Captured on a Topcon TRC-NW8 fundus camera.
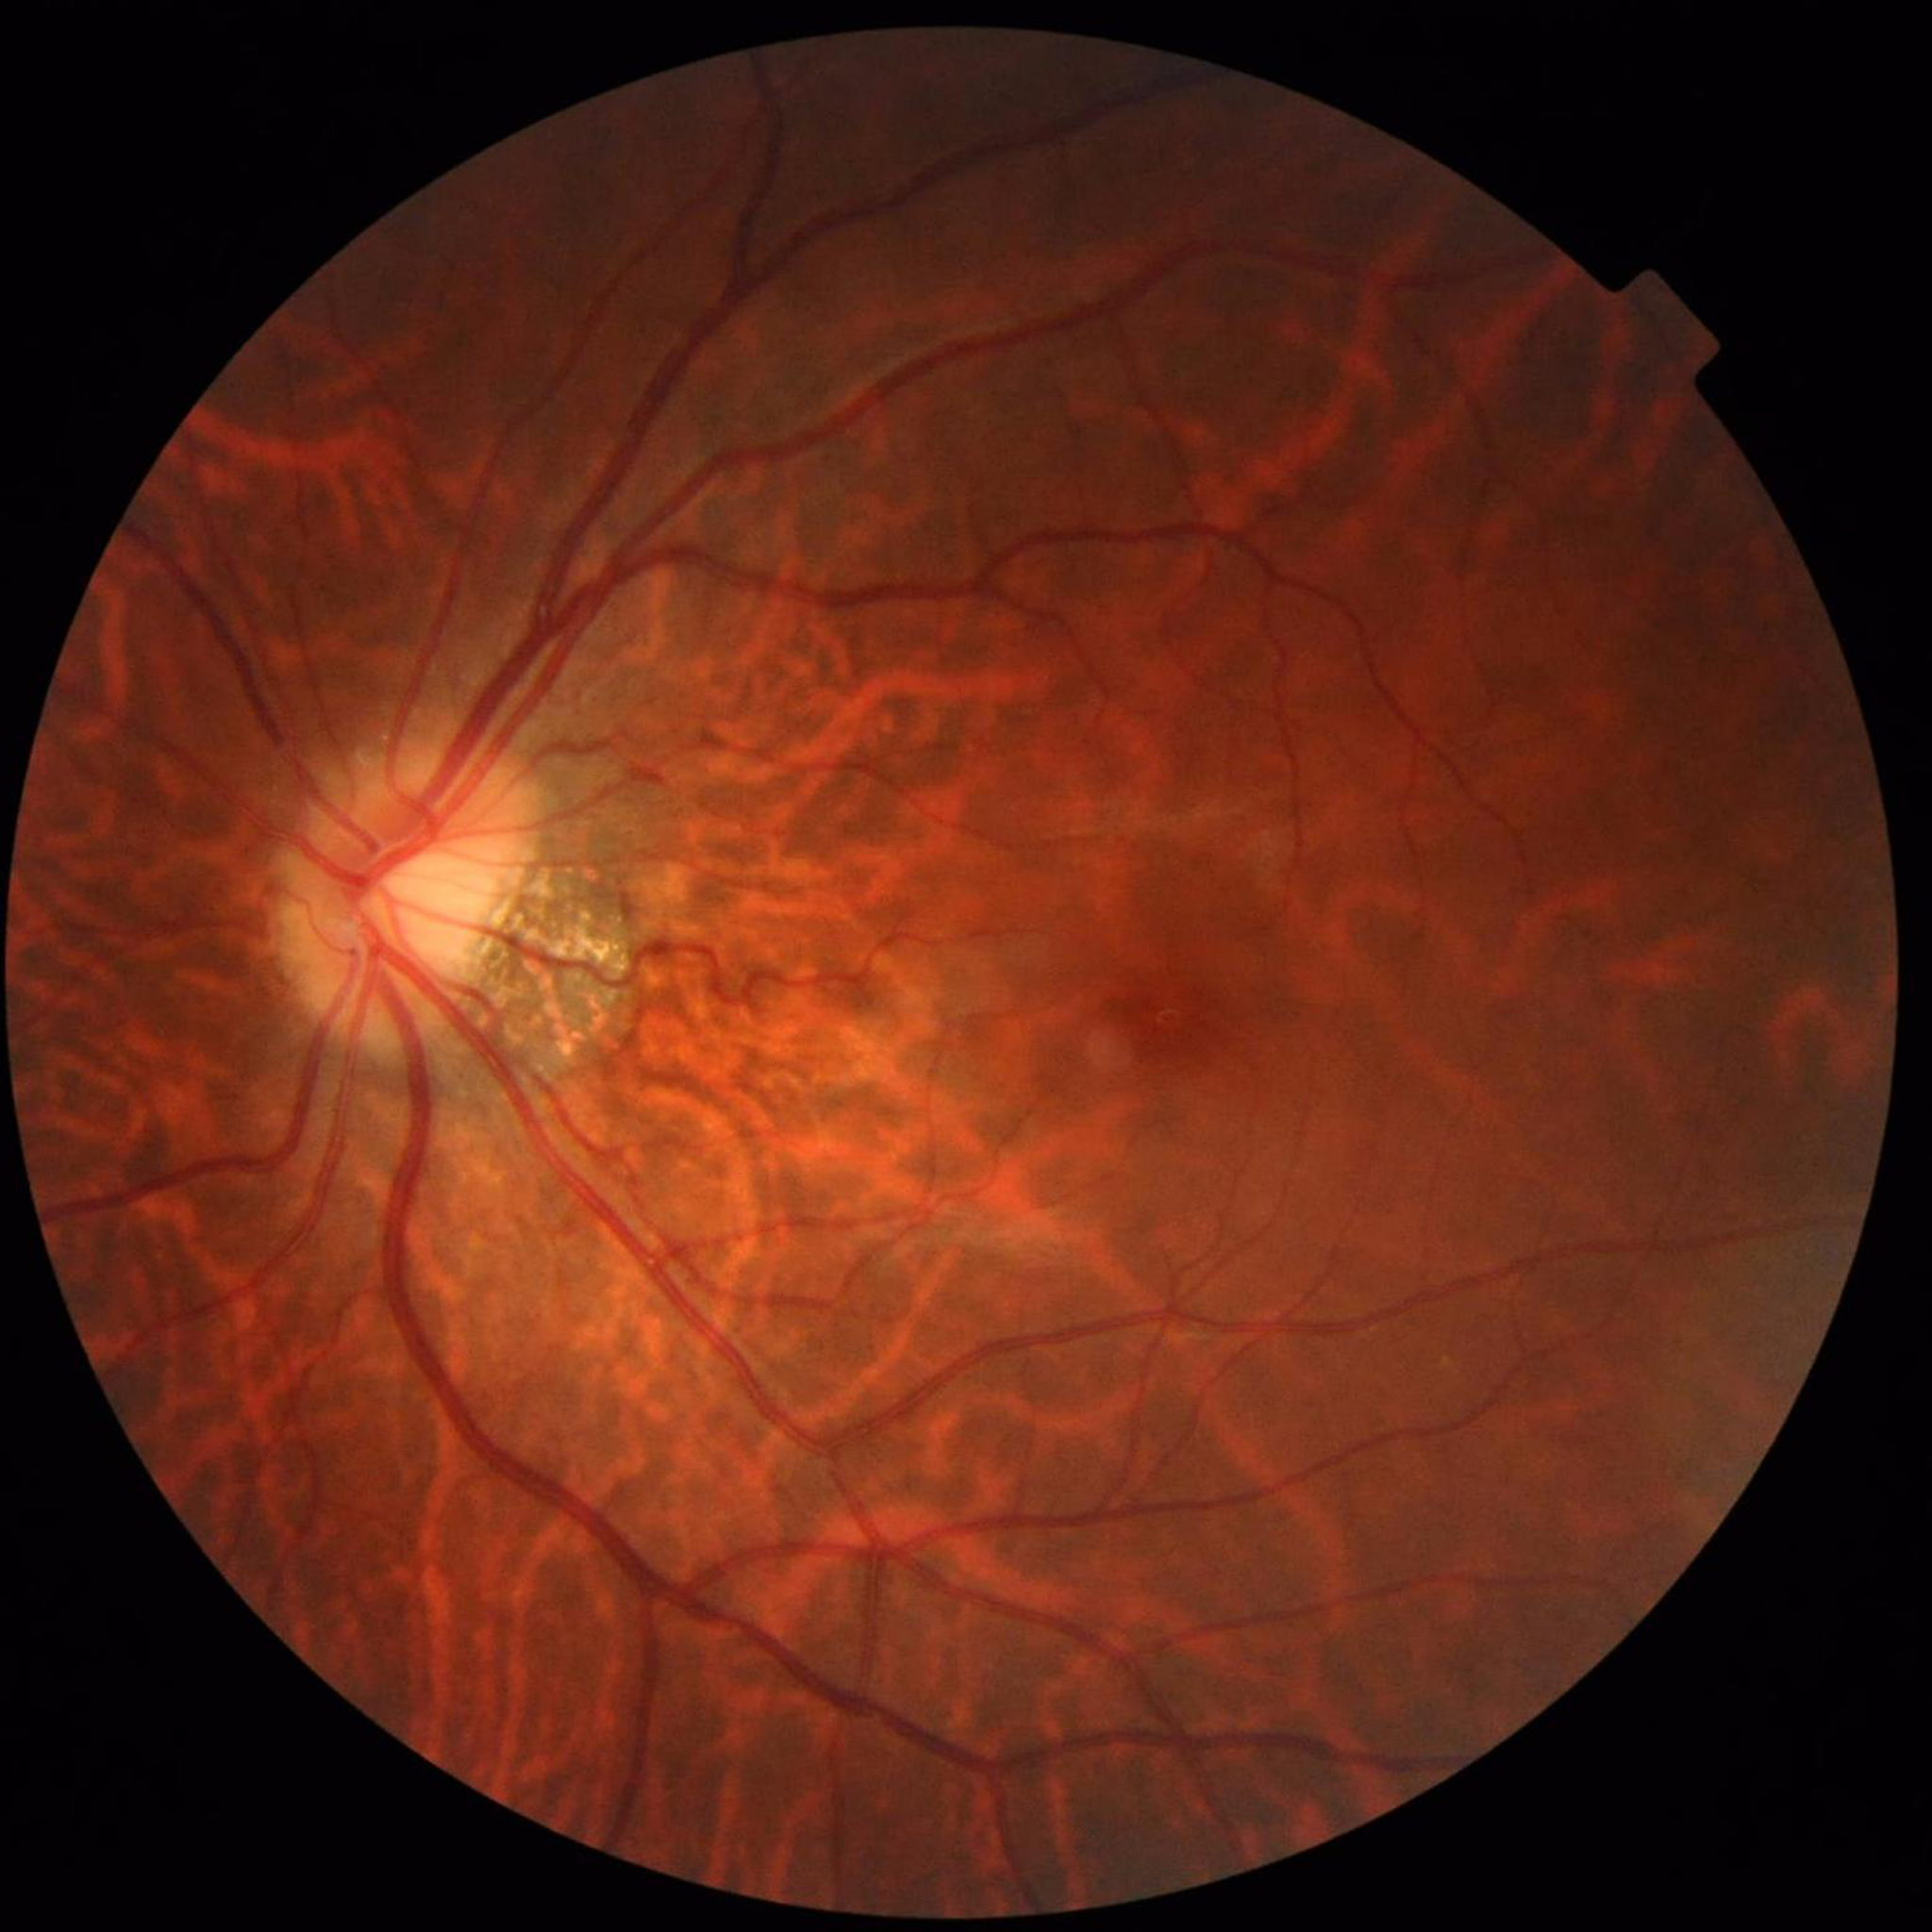

Photo quality: no concerns identified. No signs of AMD, diabetic retinopathy, or glaucoma.